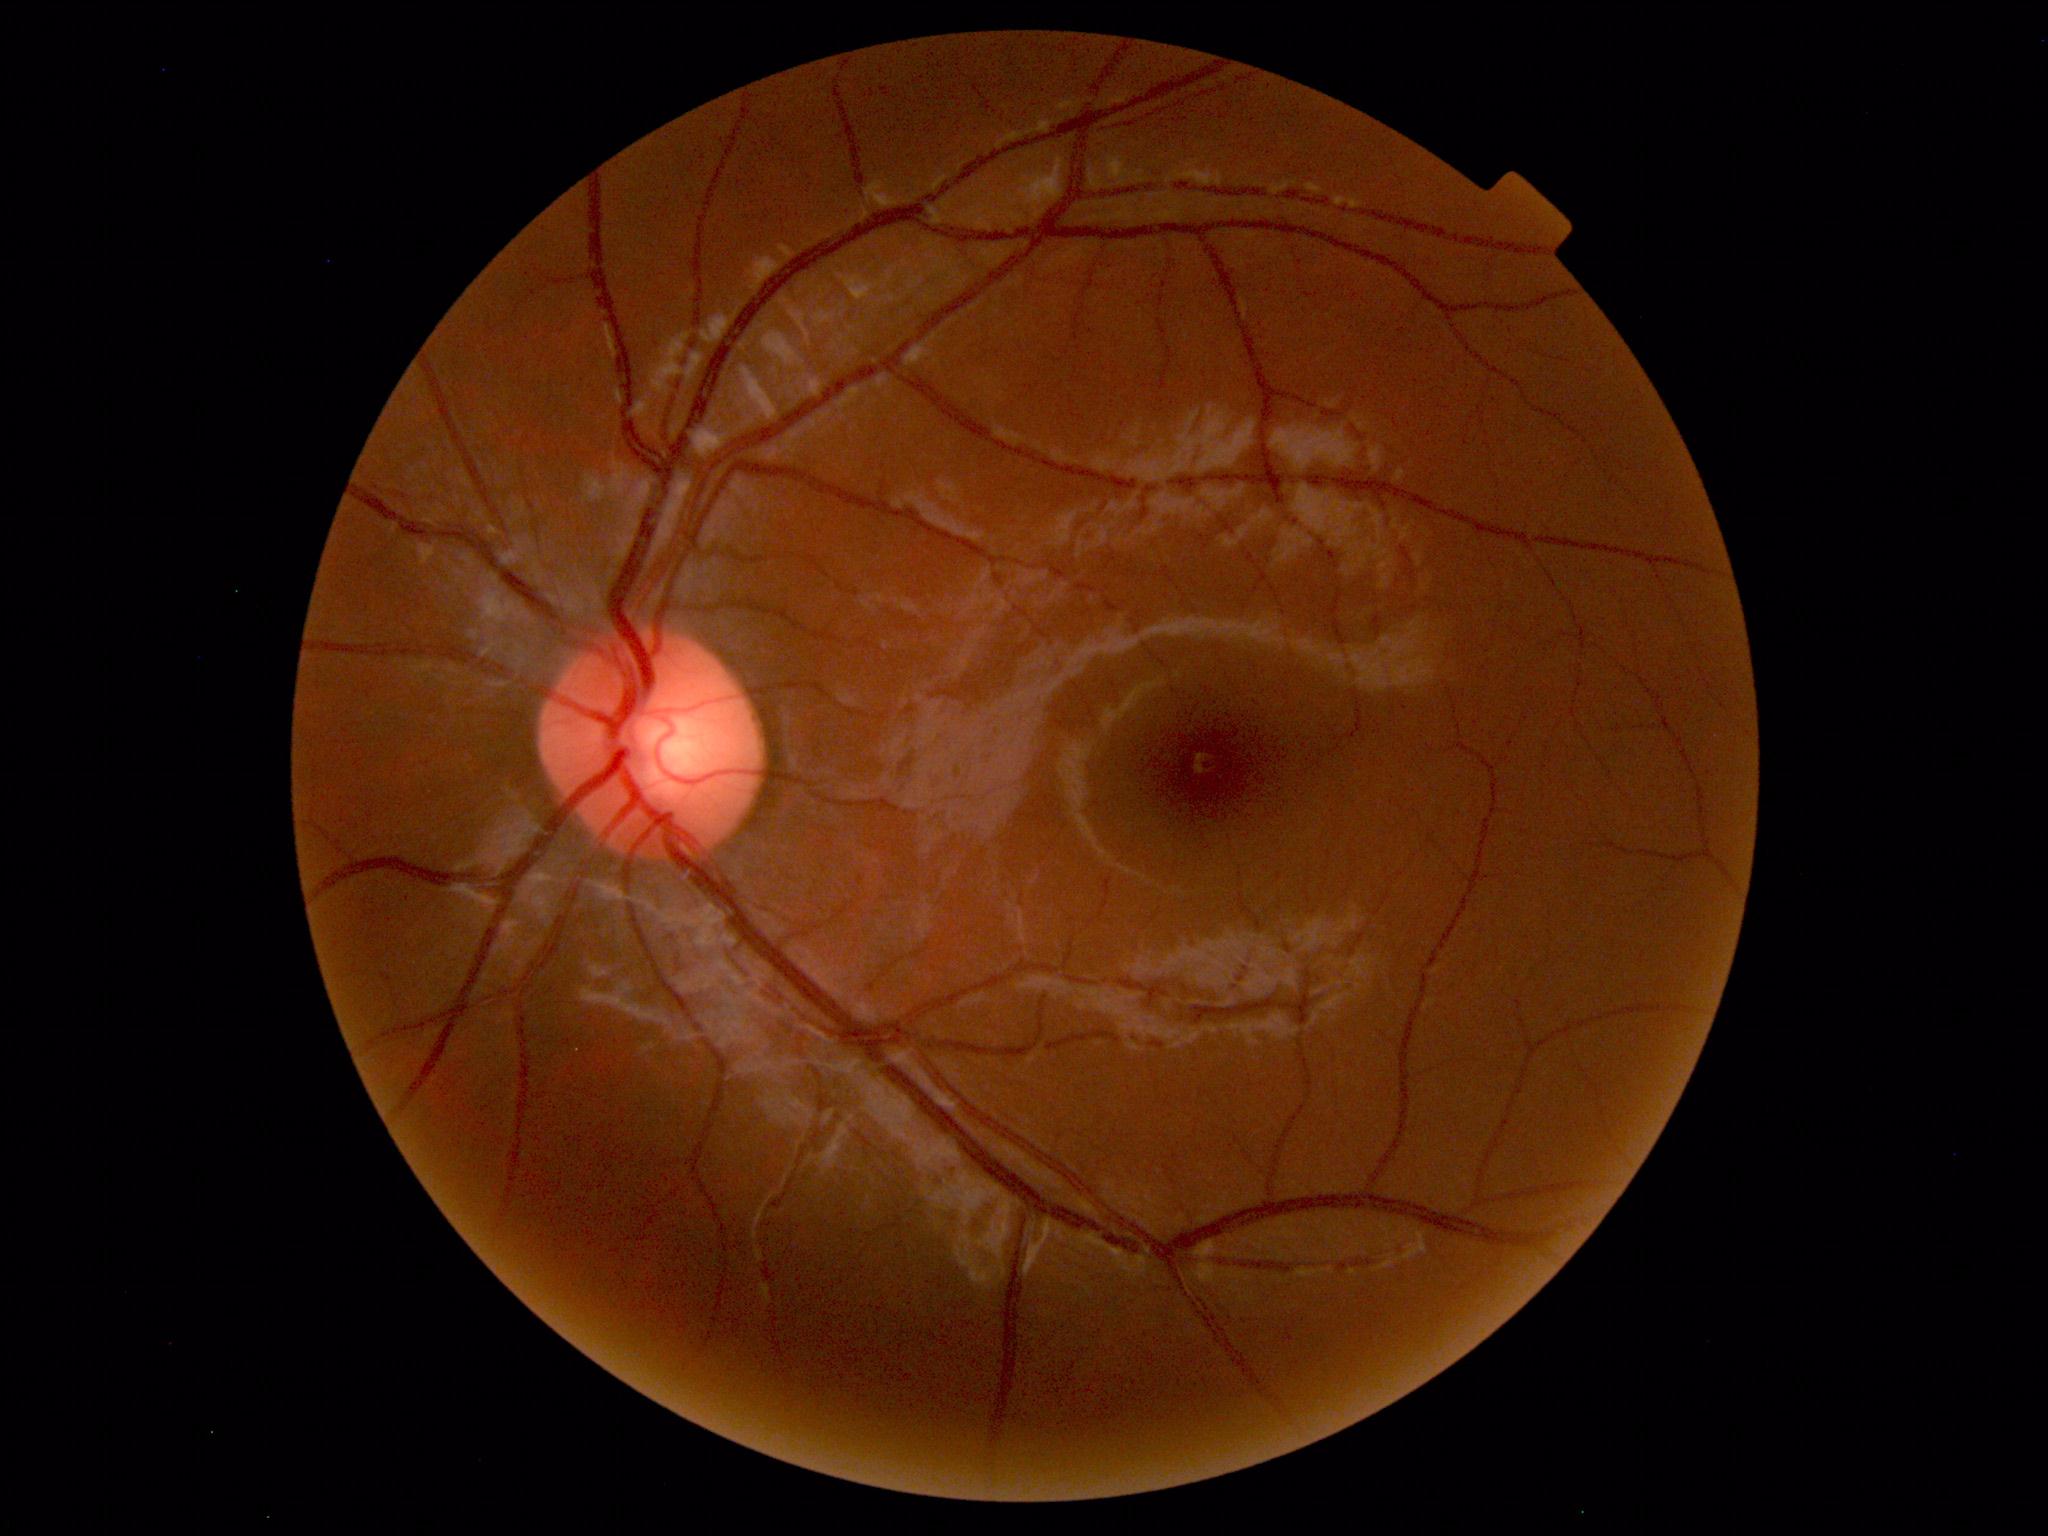

Findings: none. Normal fundus.